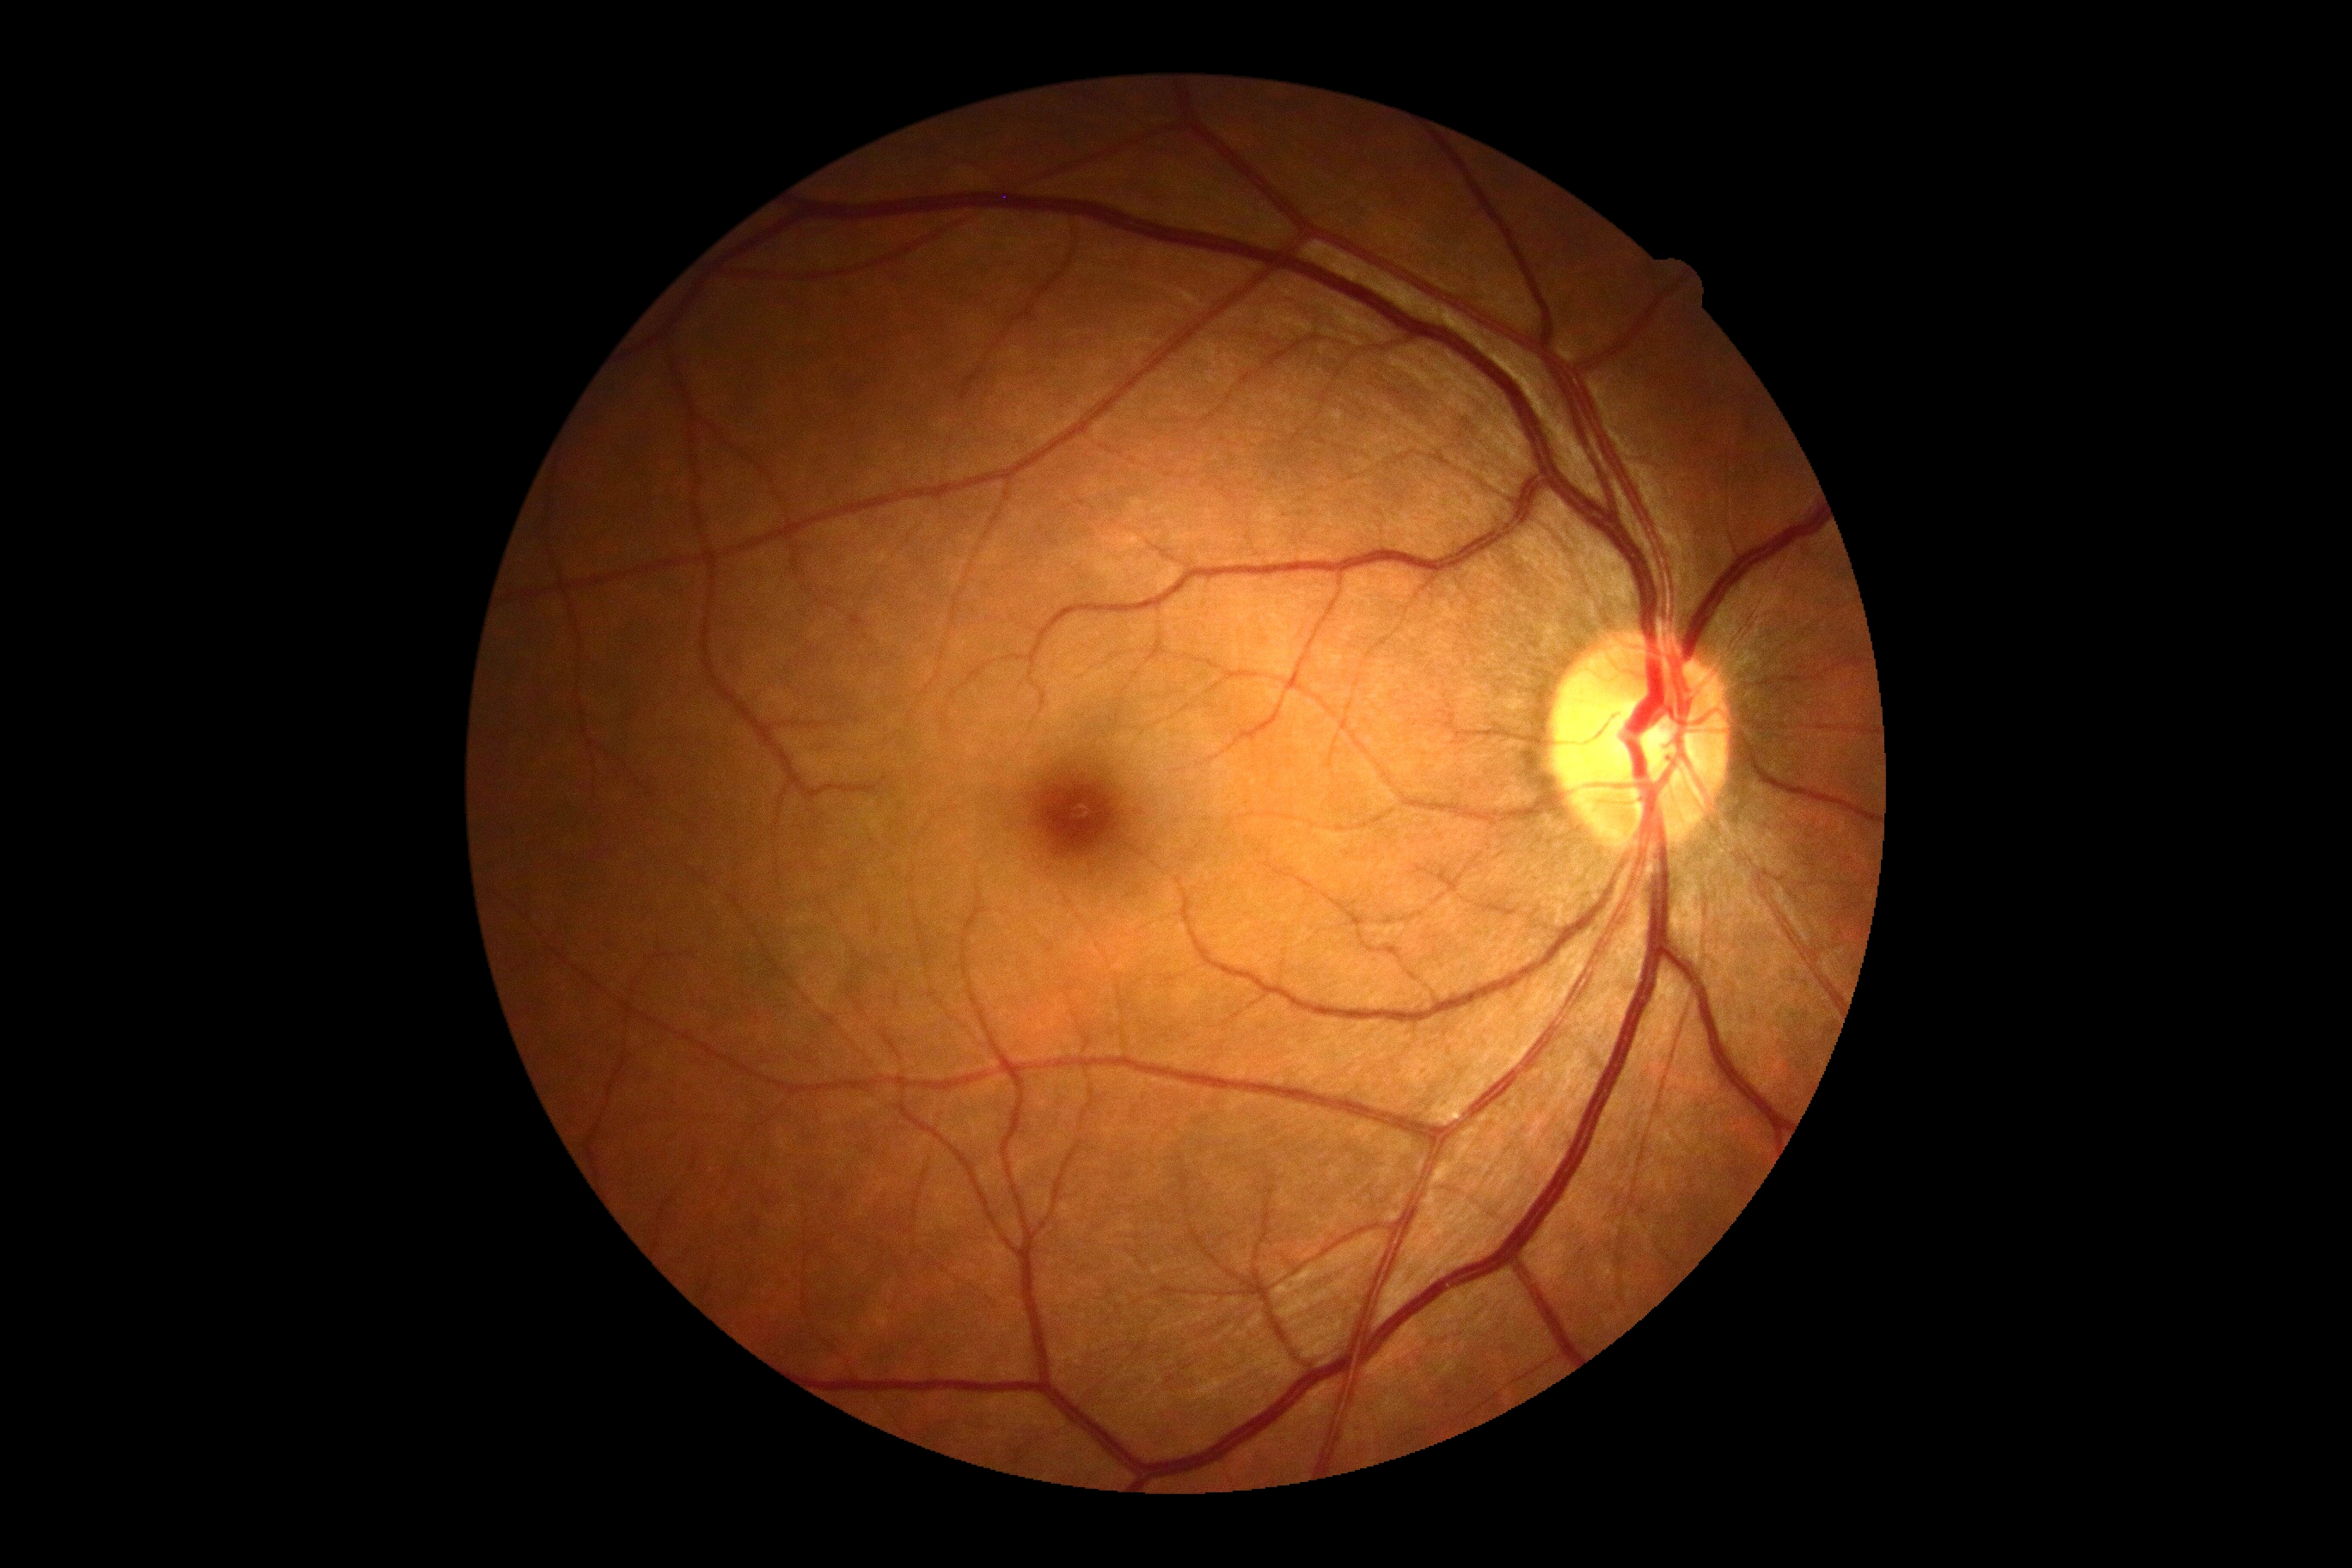

DR severity is 0.